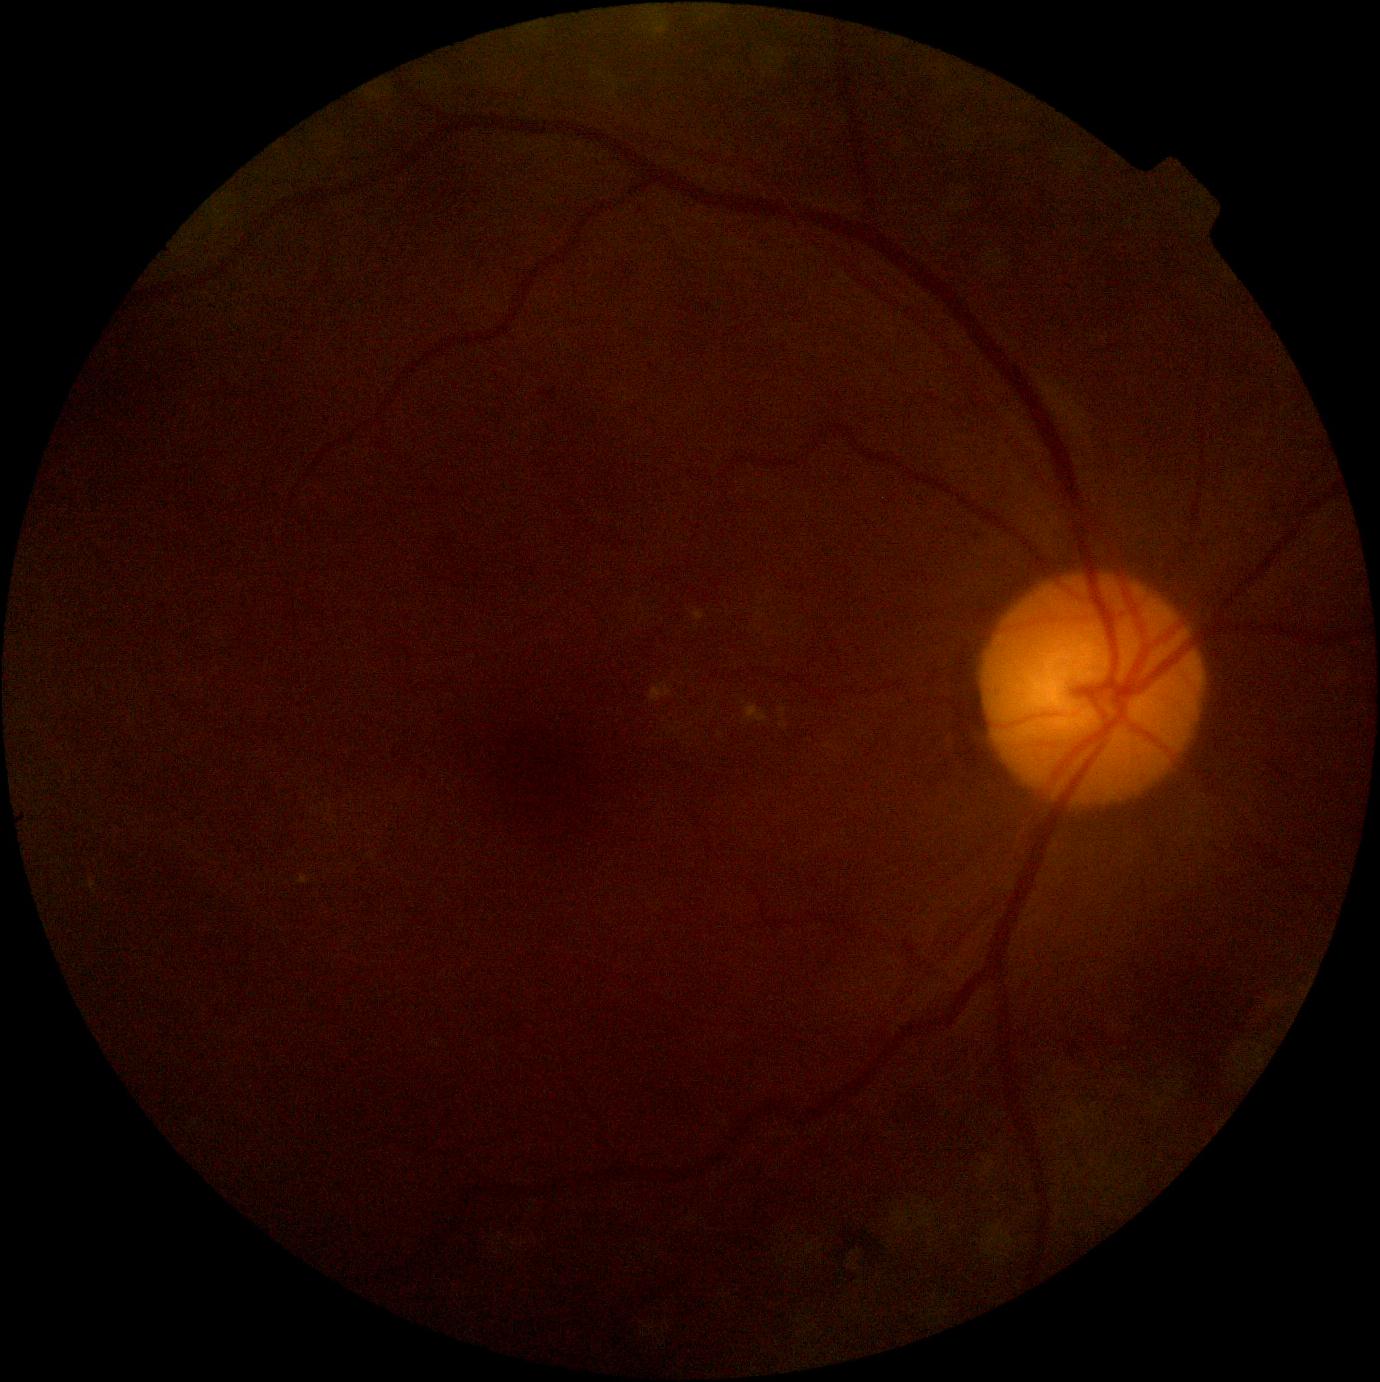 DR=grade 2, DR class=non-proliferative diabetic retinopathy.